Without pupil dilation
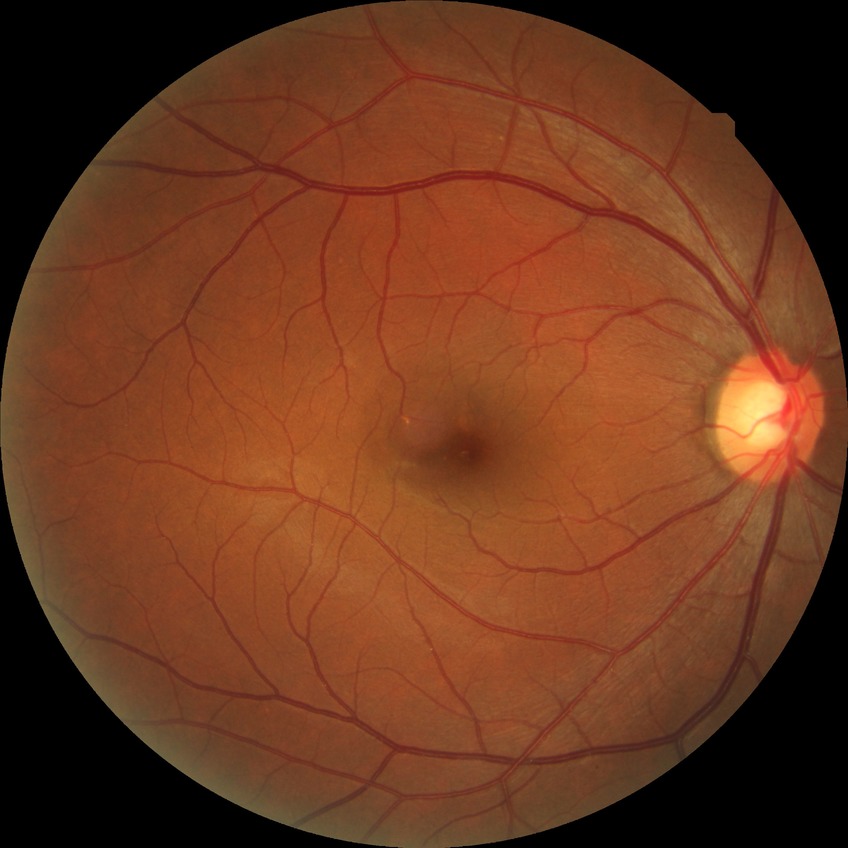 Modified Davis classification: no diabetic retinopathy.